Infant wide-field retinal image. Image size 640x480 — 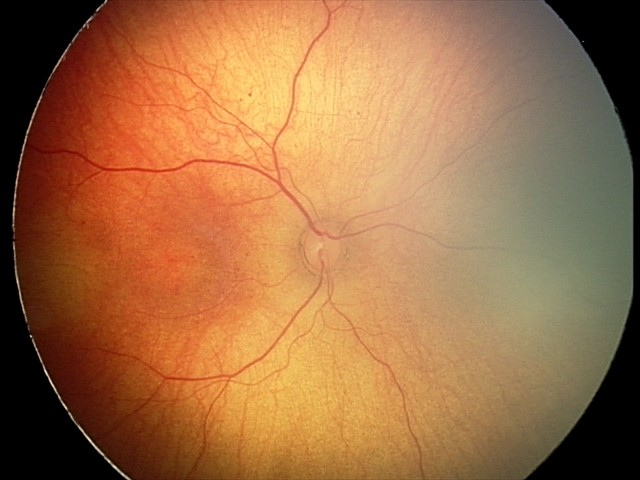 Normal screening examination.